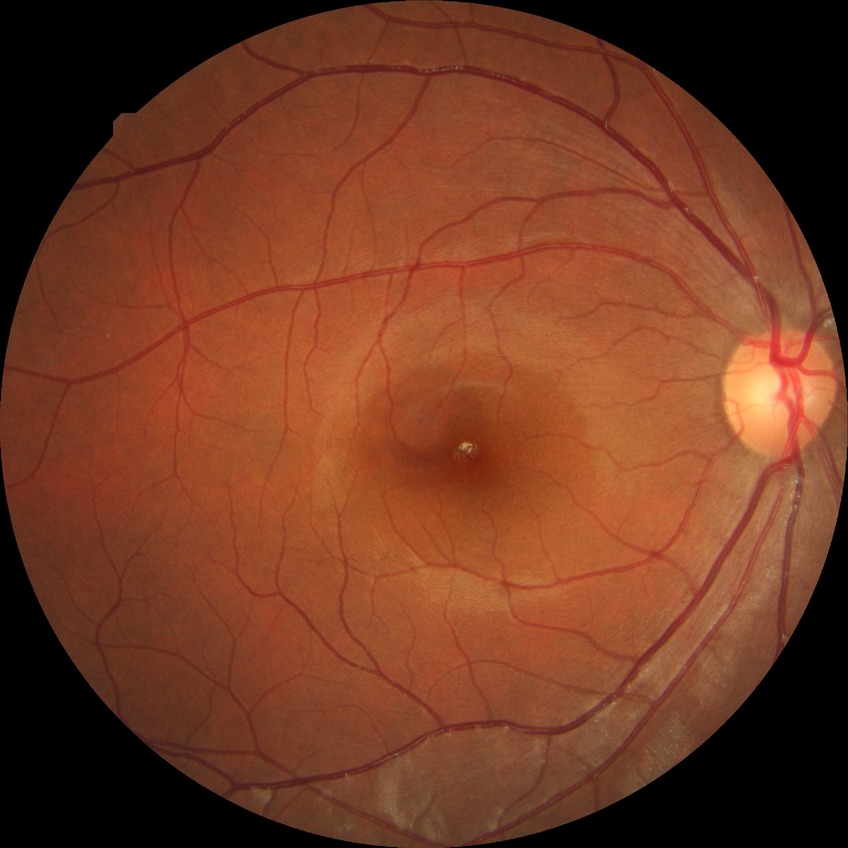
DR impression: no DR findings; DR severity: NDR.